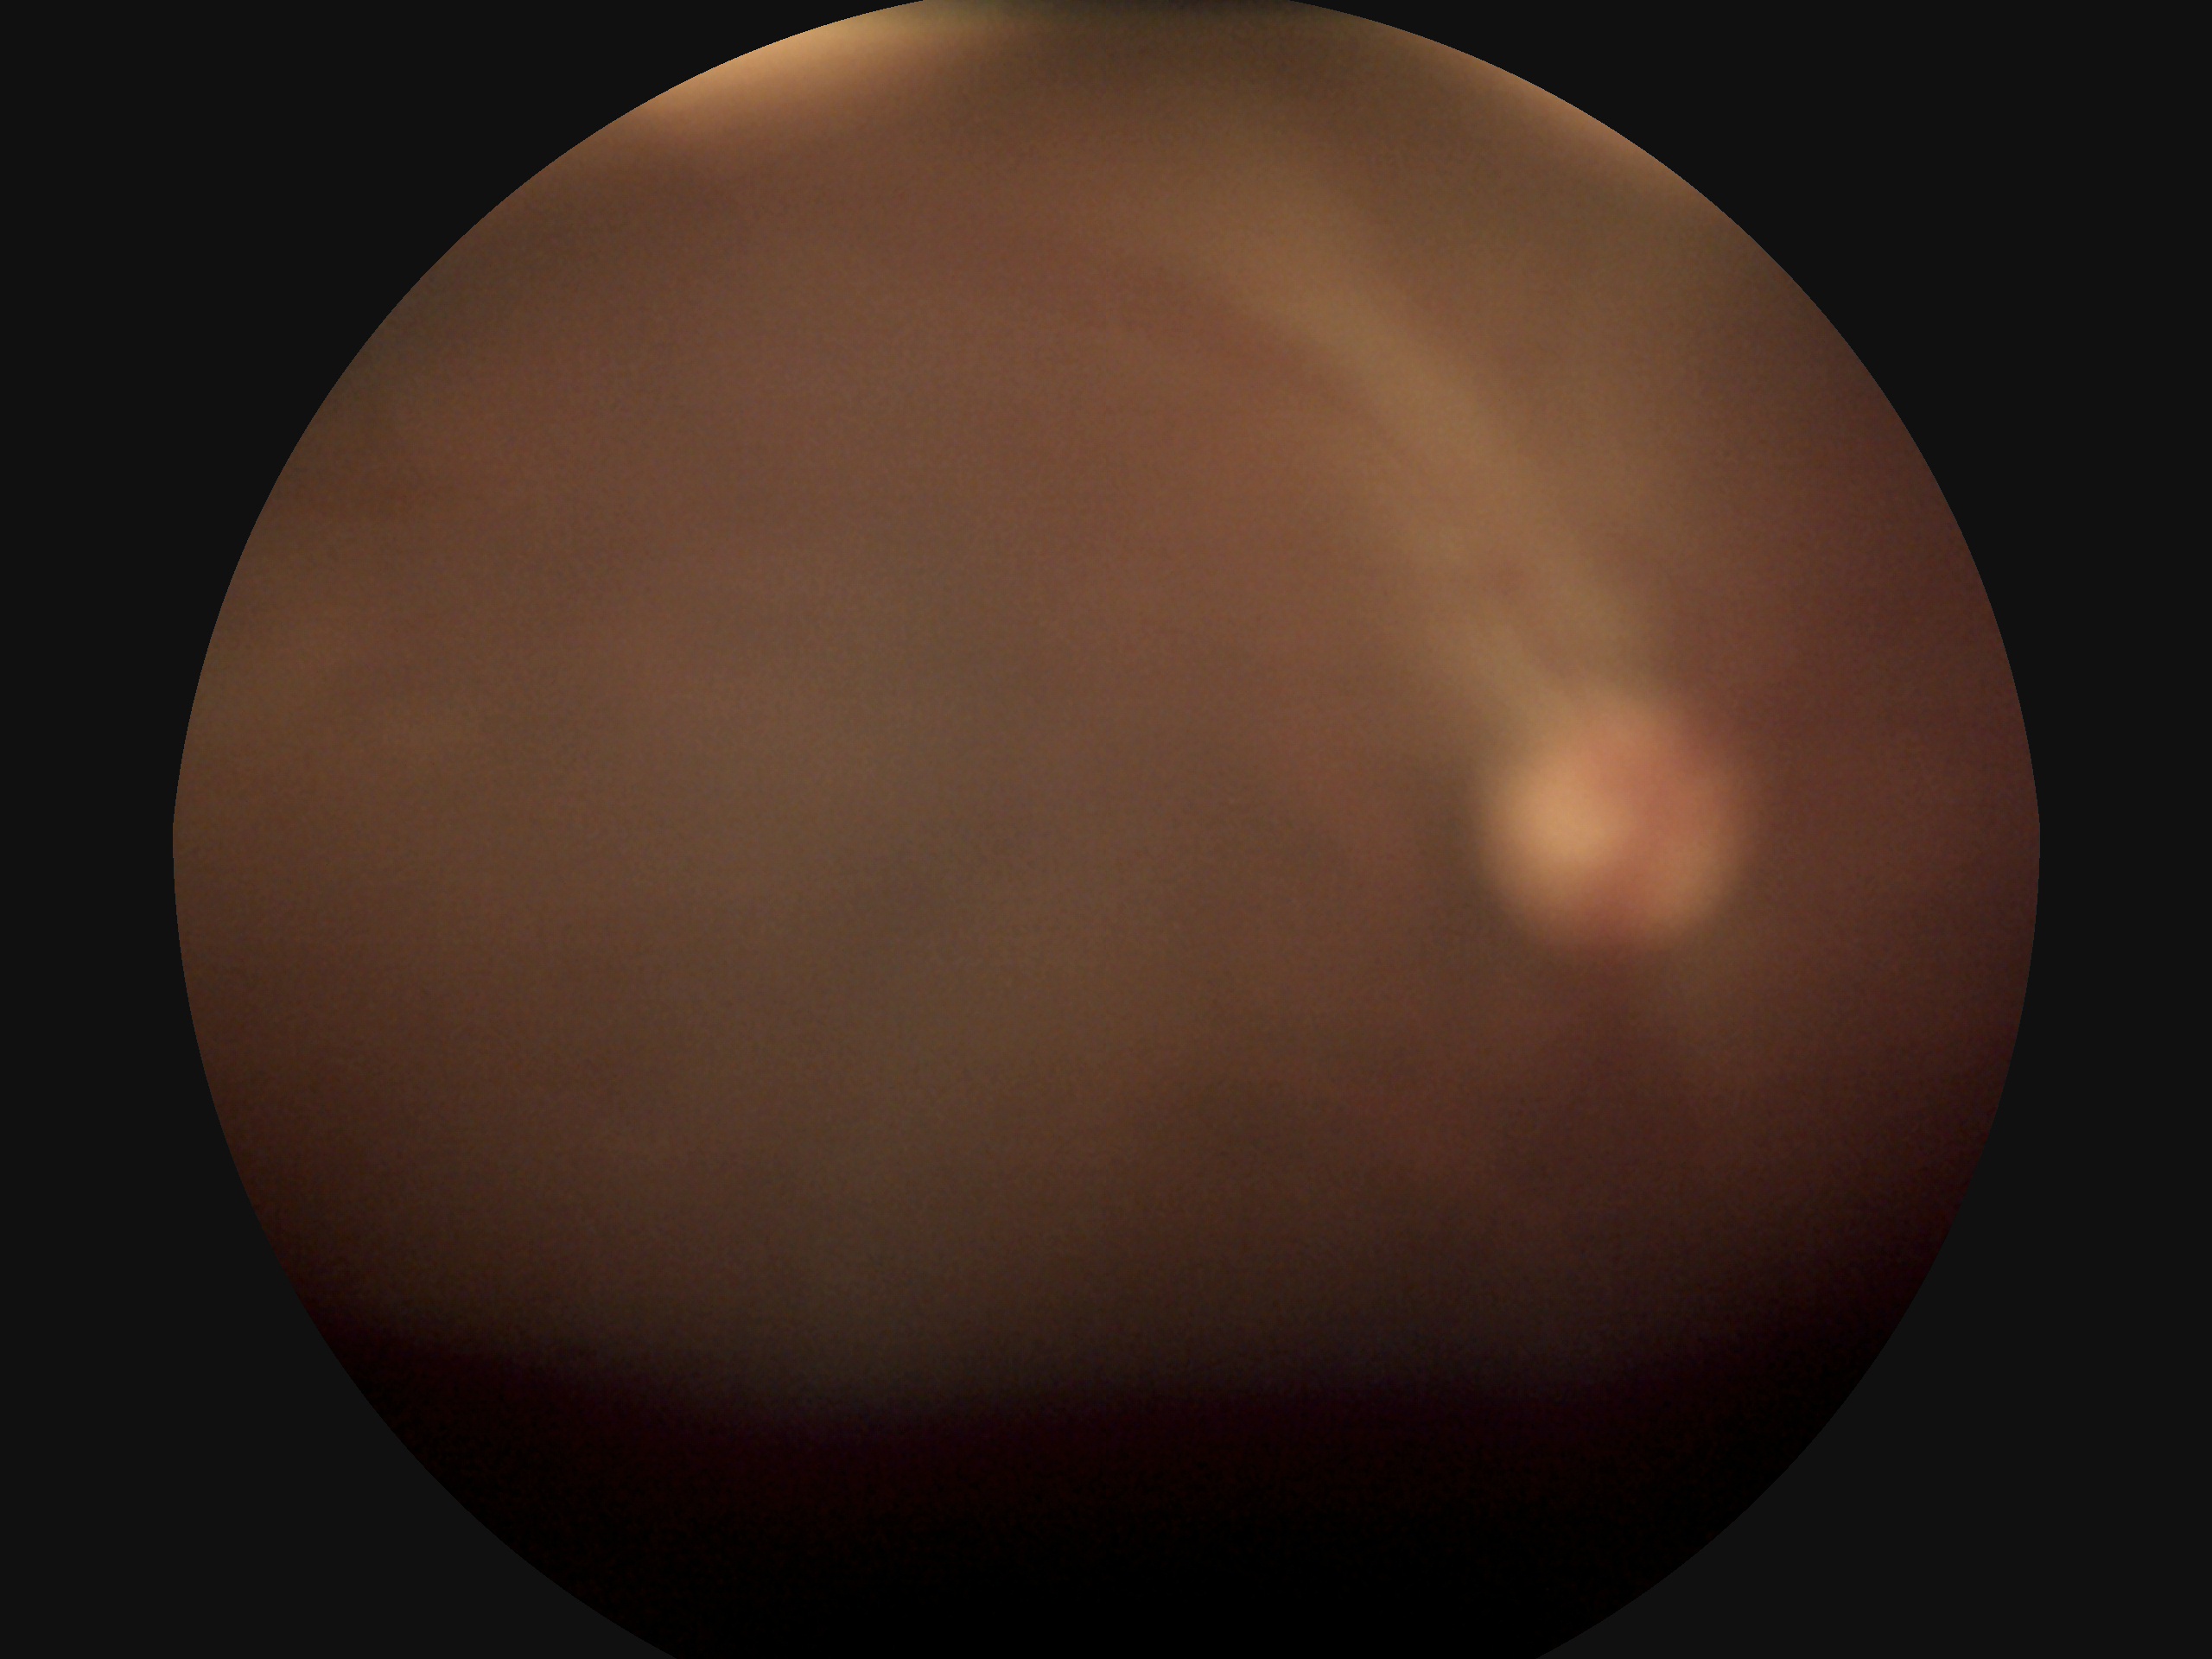 DR: ungradable due to poor image quality.